Image size 2048x1536 — 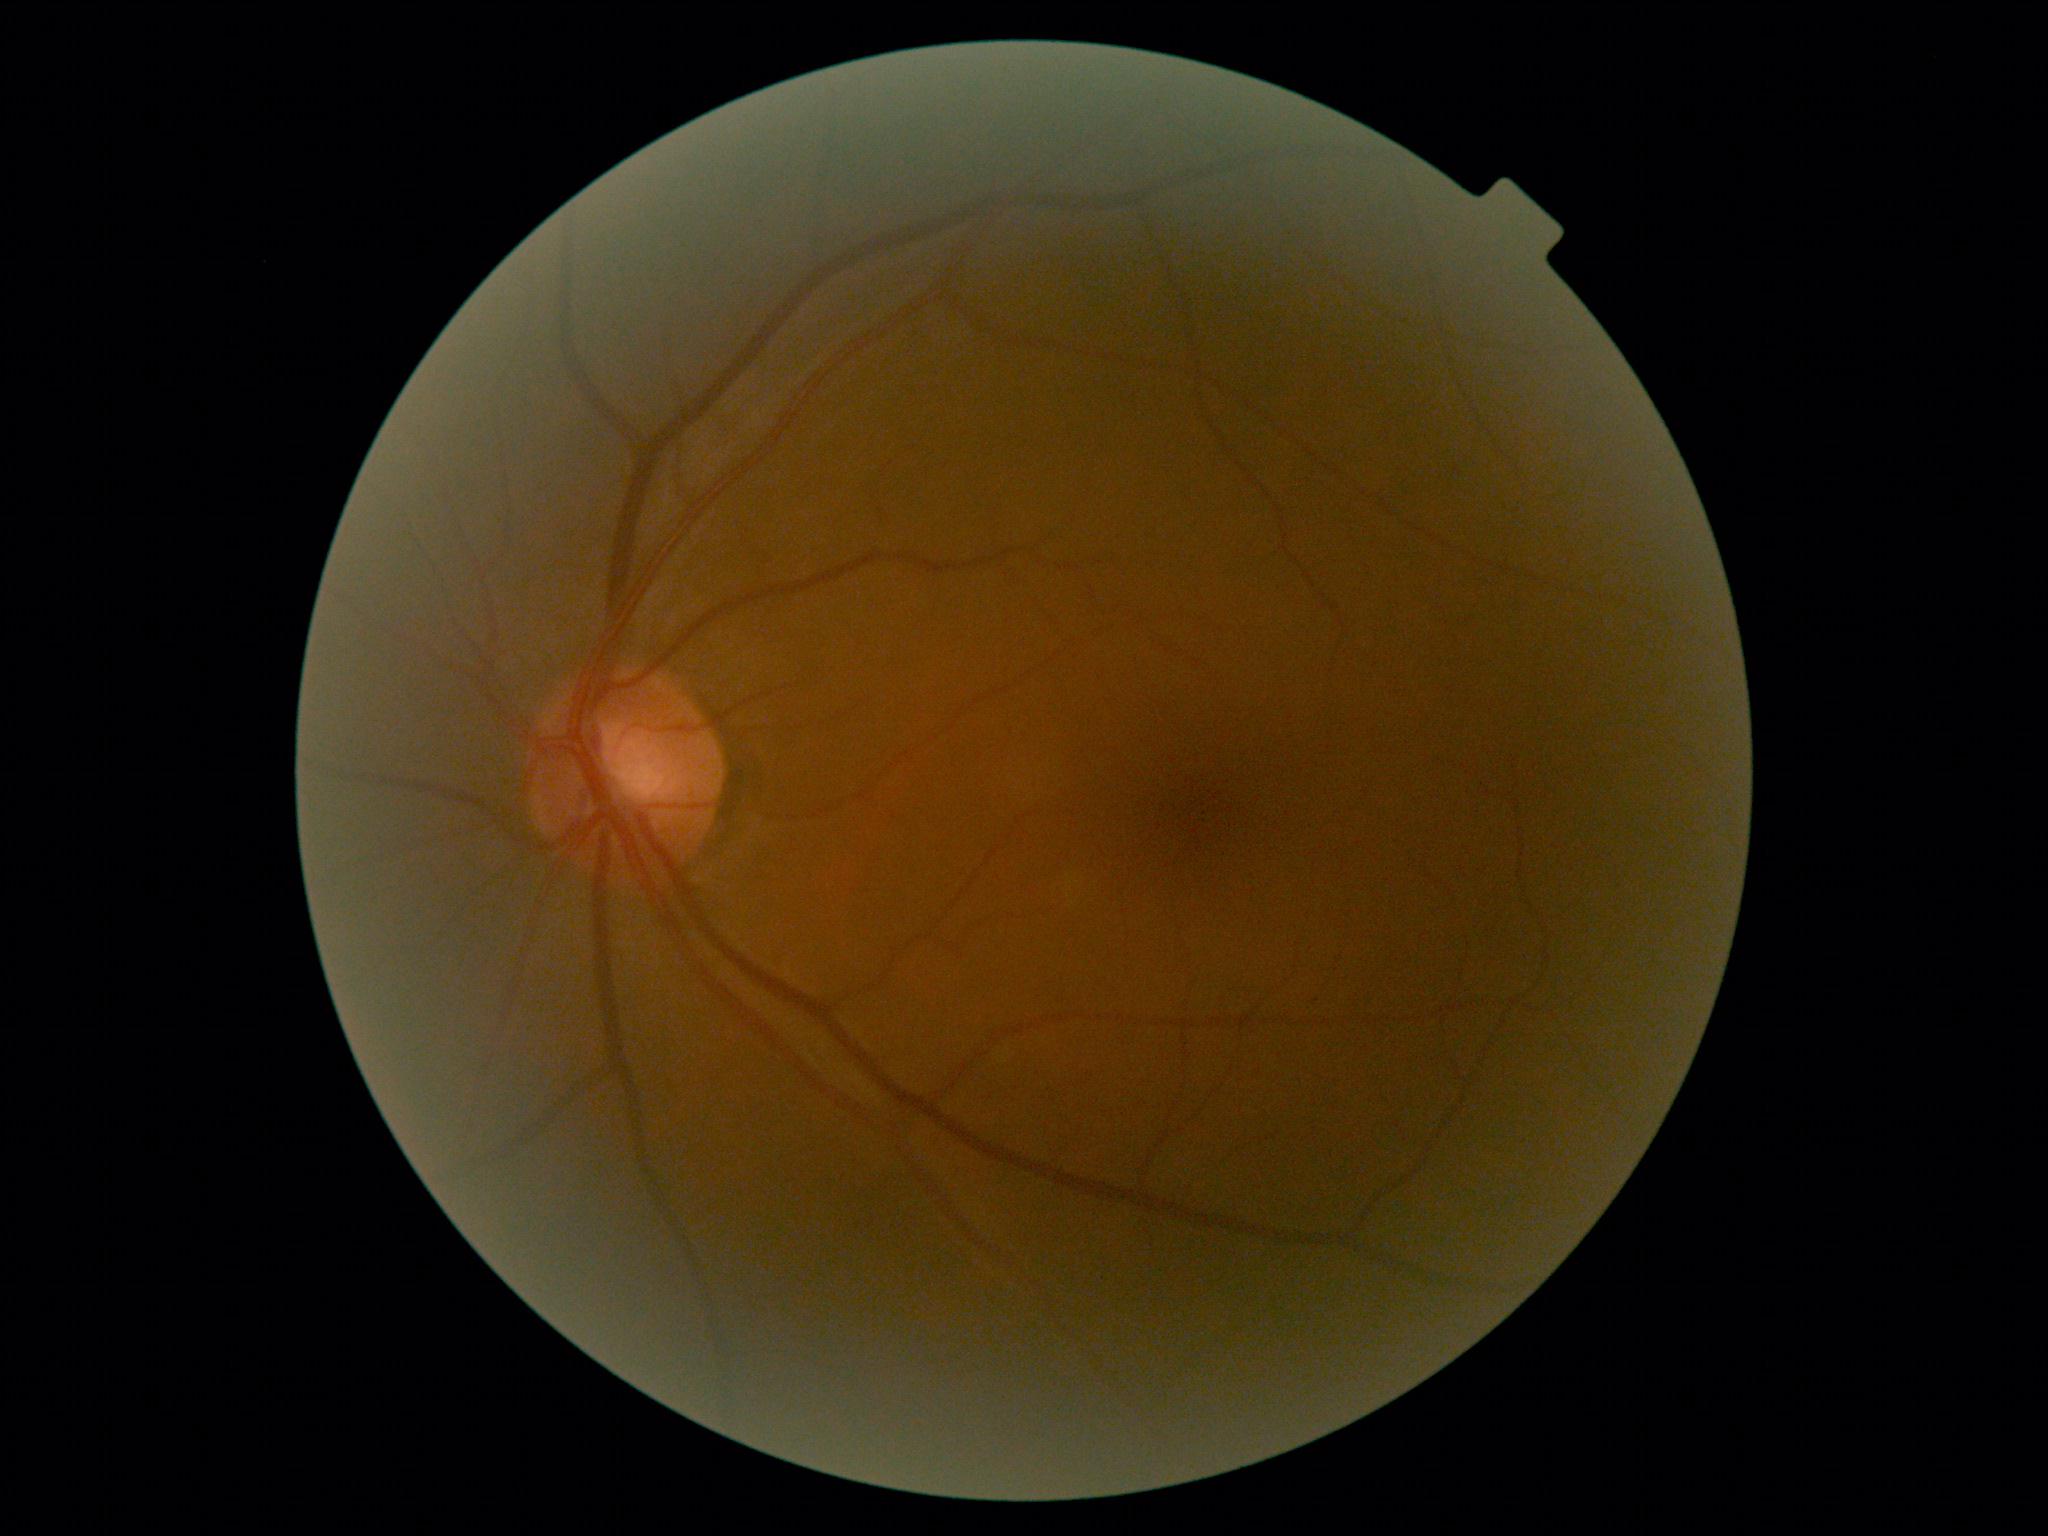
diabetic retinopathy (DR): no apparent diabetic retinopathy (grade 0) — no visible signs of diabetic retinopathy.